Wide-field fundus photograph from neonatal ROP screening
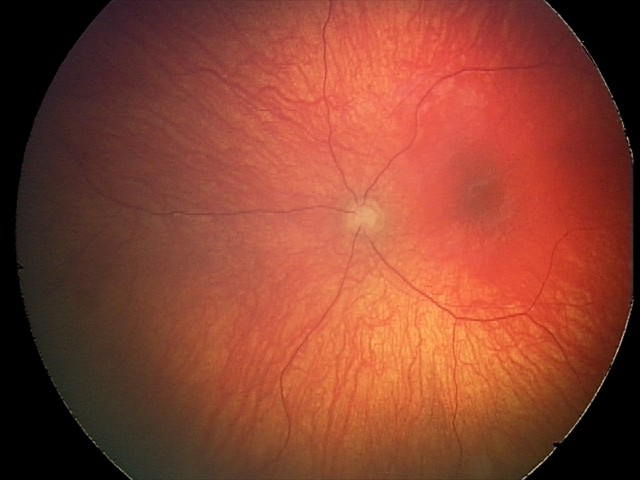 Impression: optic nerve hypoplasia.